Wide-field fundus photograph from neonatal ROP screening · 1240x1240: 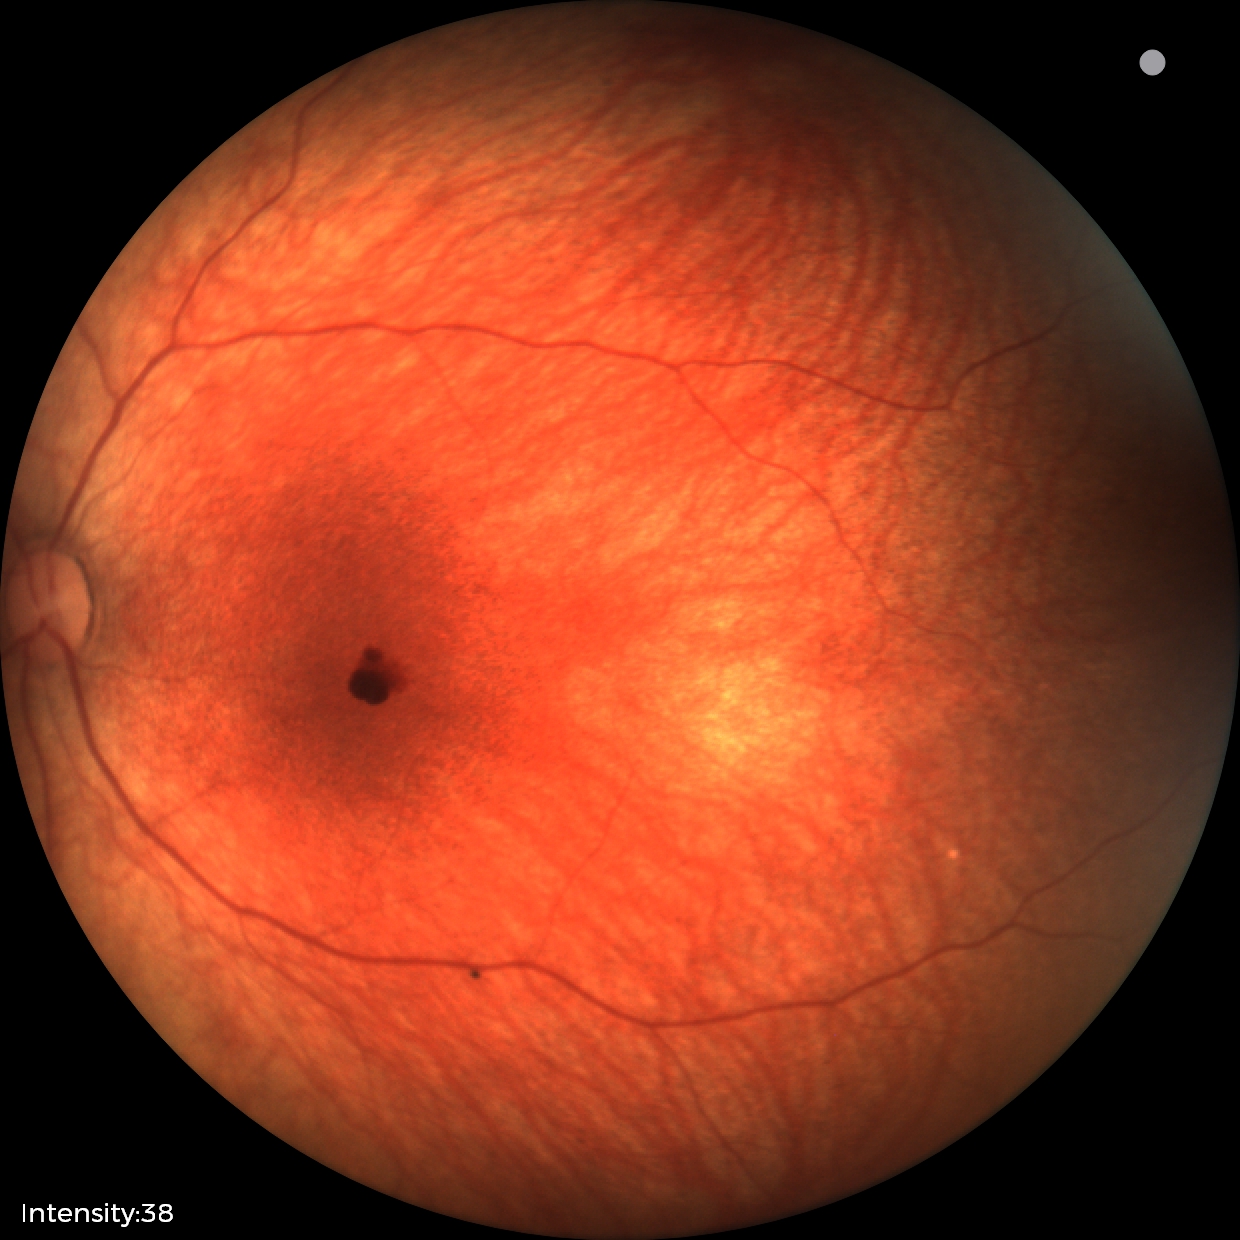

Screening examination consistent with retinal hemorrhages.